45-degree field of view: 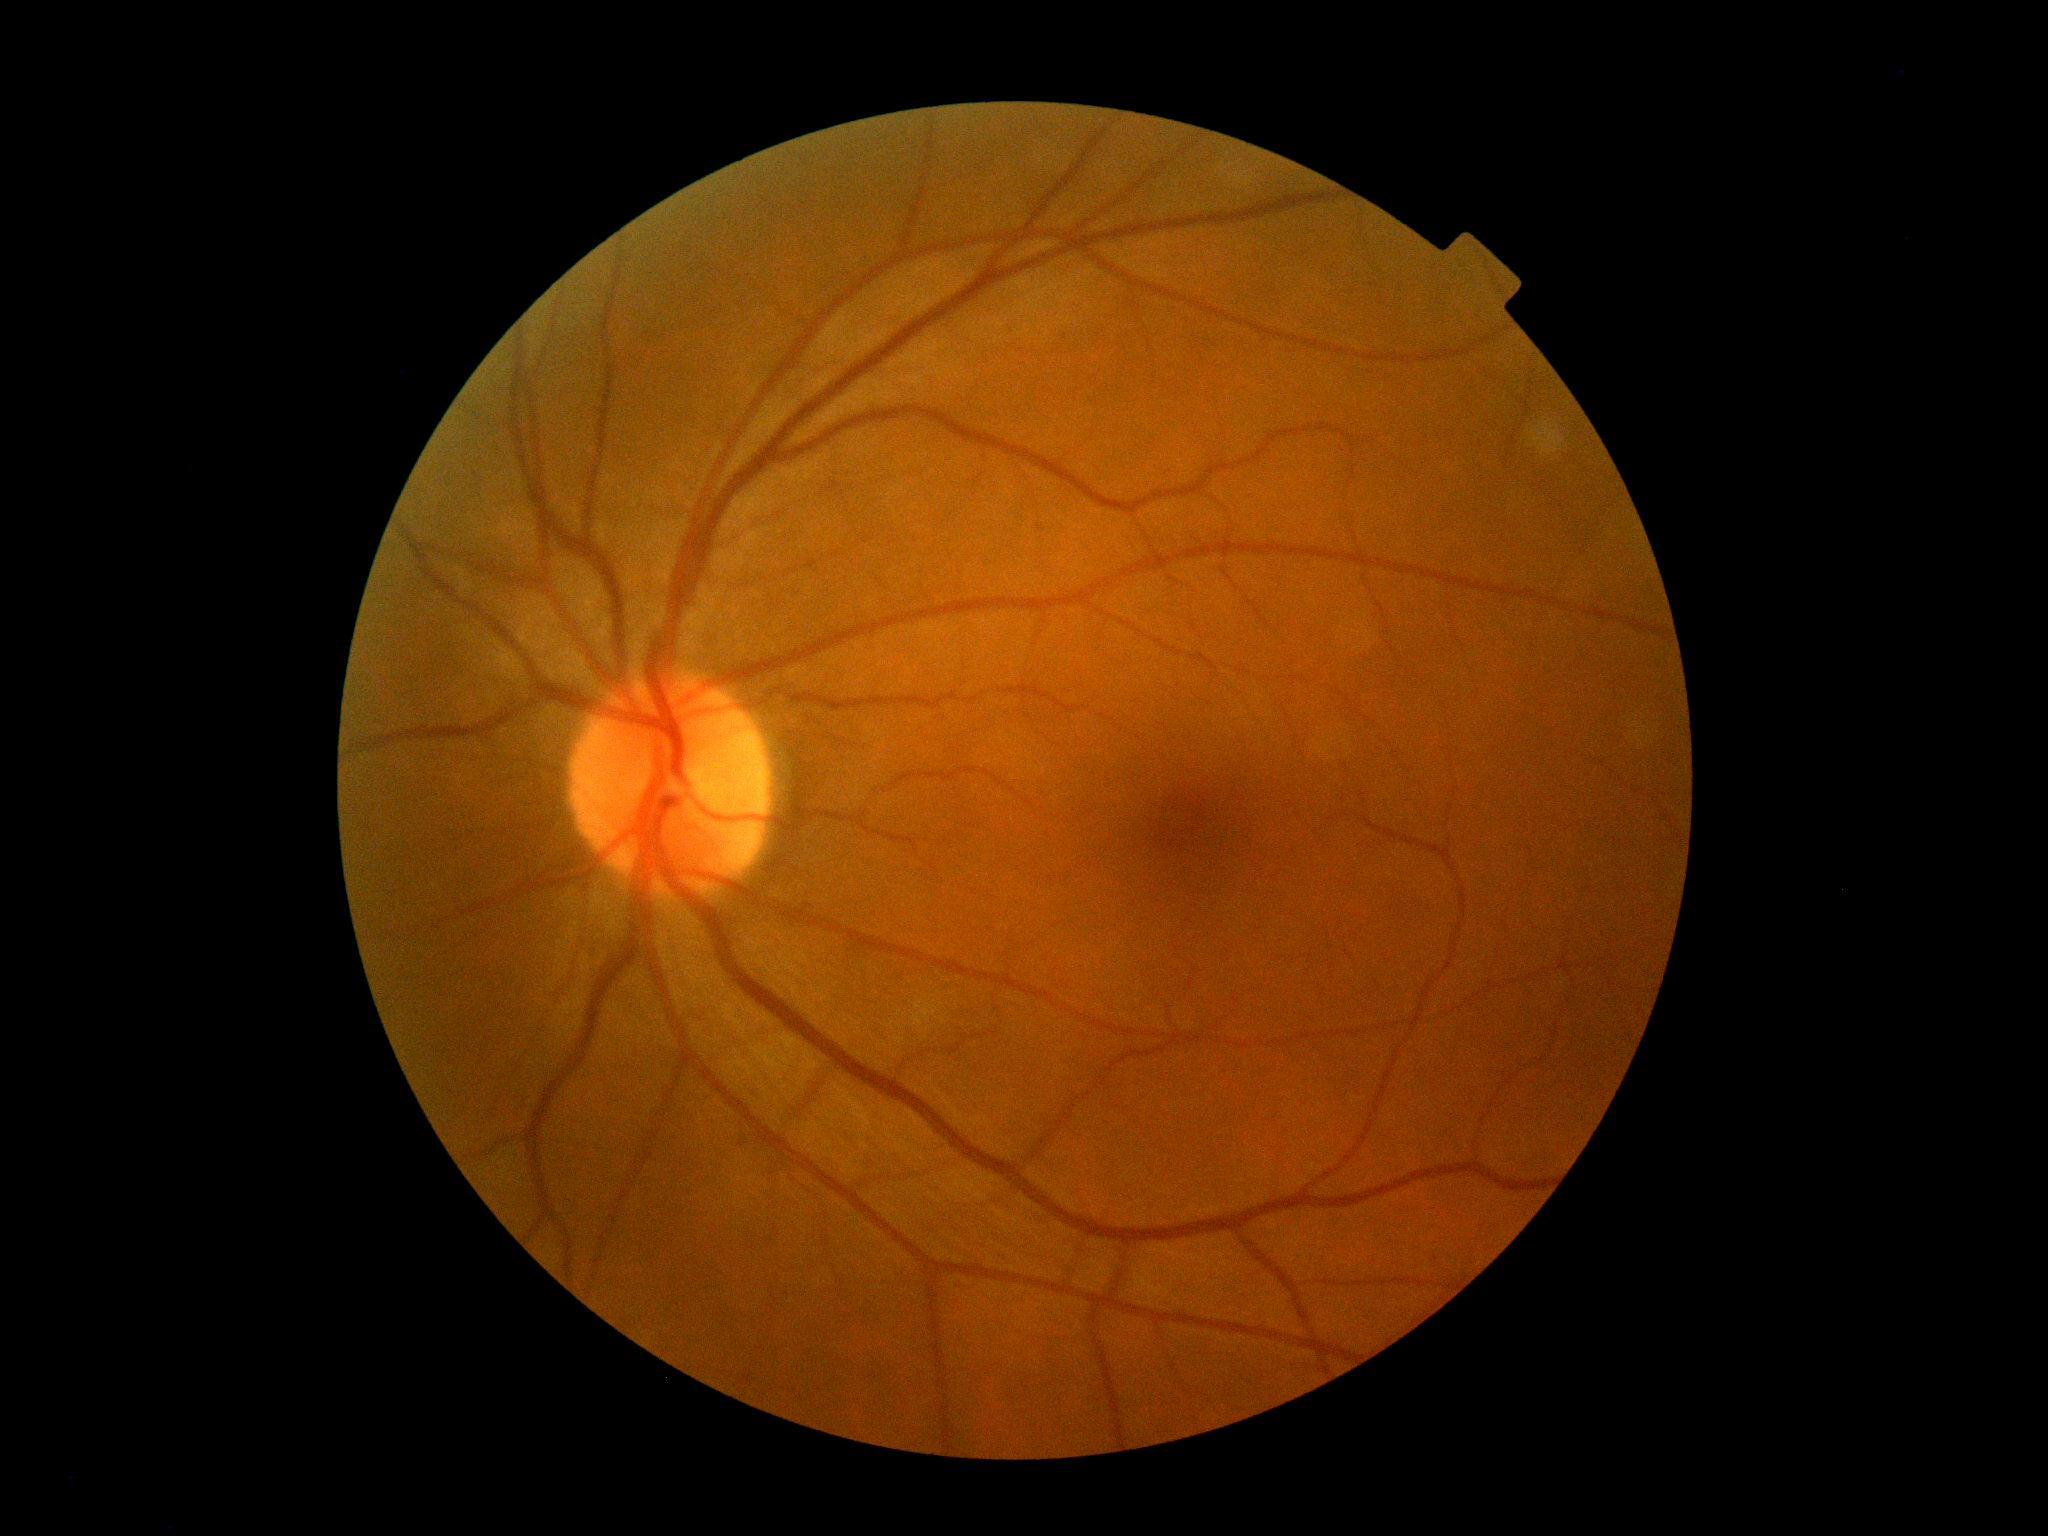   dr_grade: grade 0